2352 by 1568 pixels. Retinal fundus photograph.
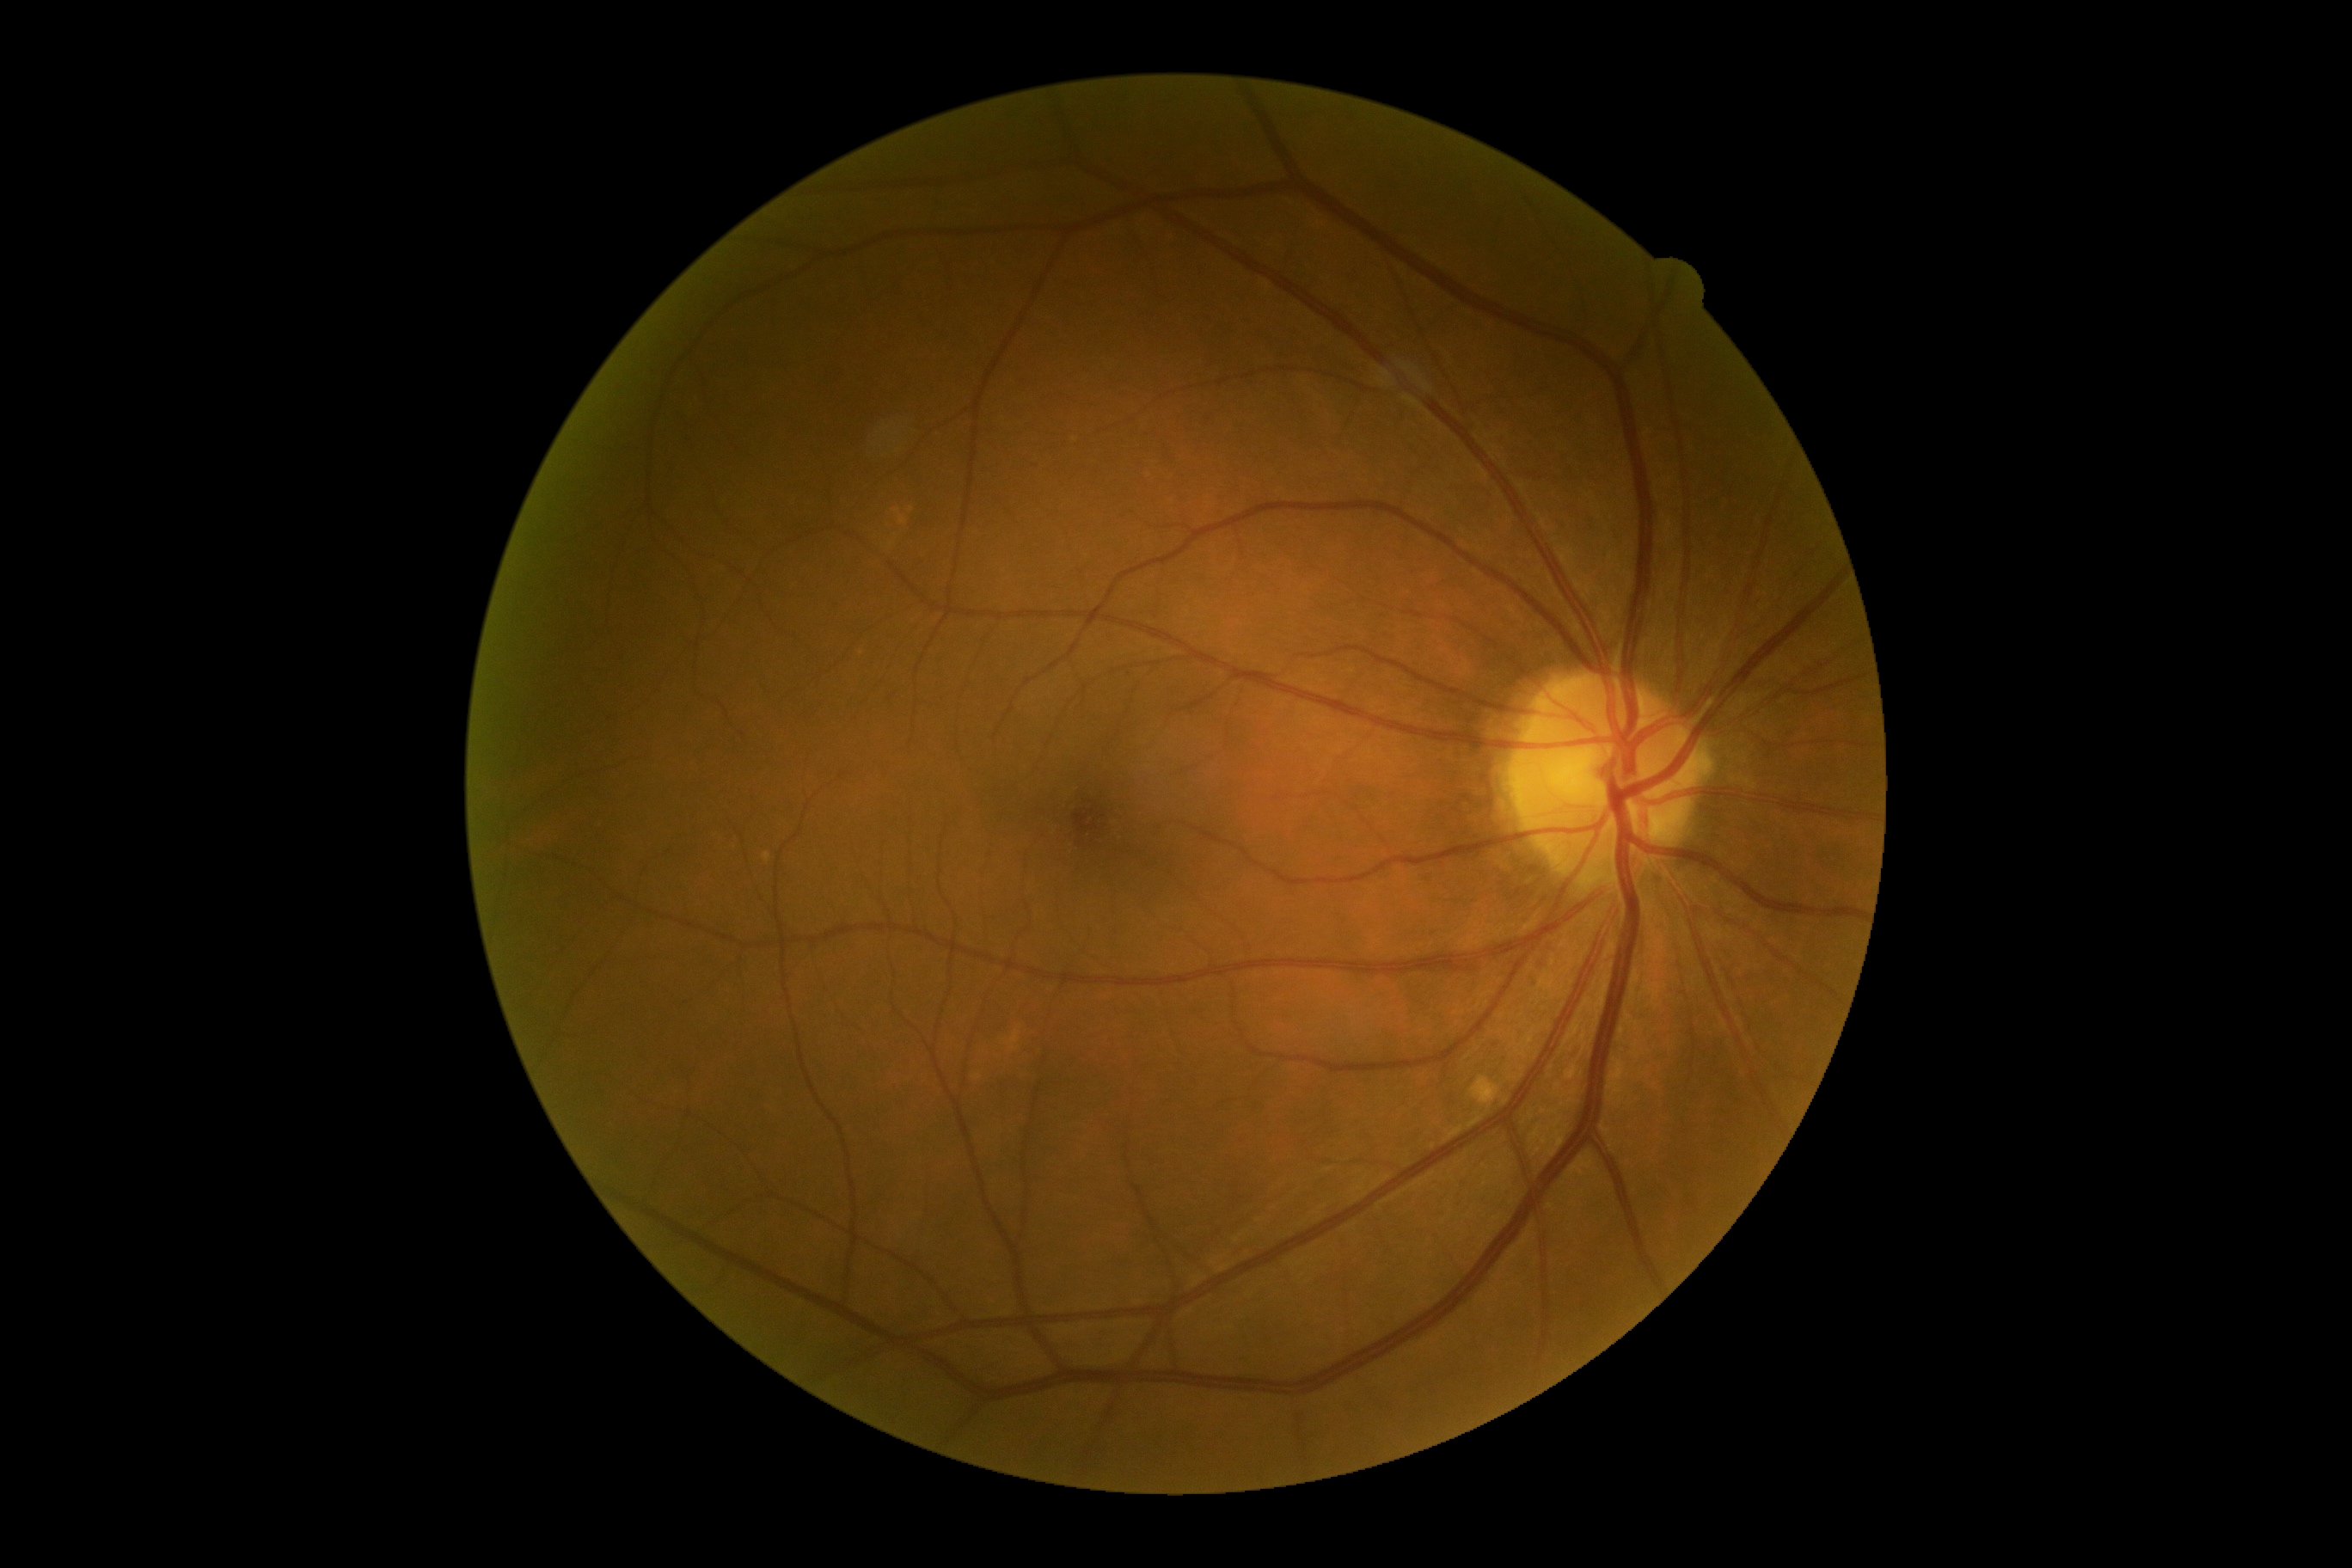
DR severity = 0/4